Wide-field fundus photograph of an infant — 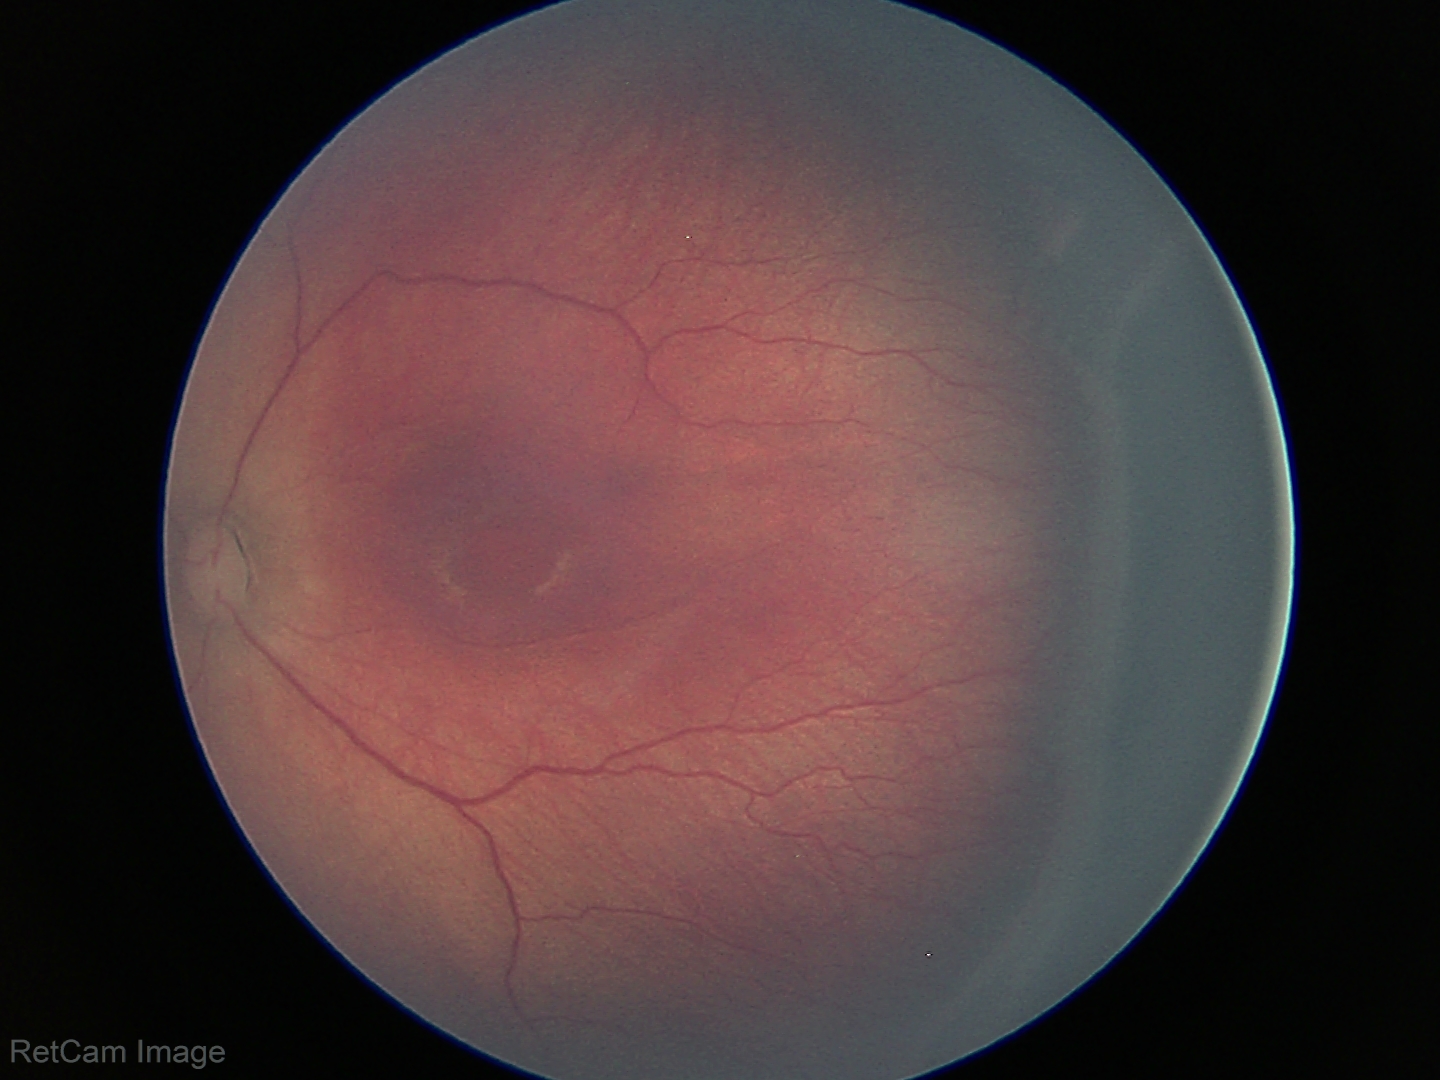

Plus disease absent. Diagnosis from this screening exam: ROP stage 3.